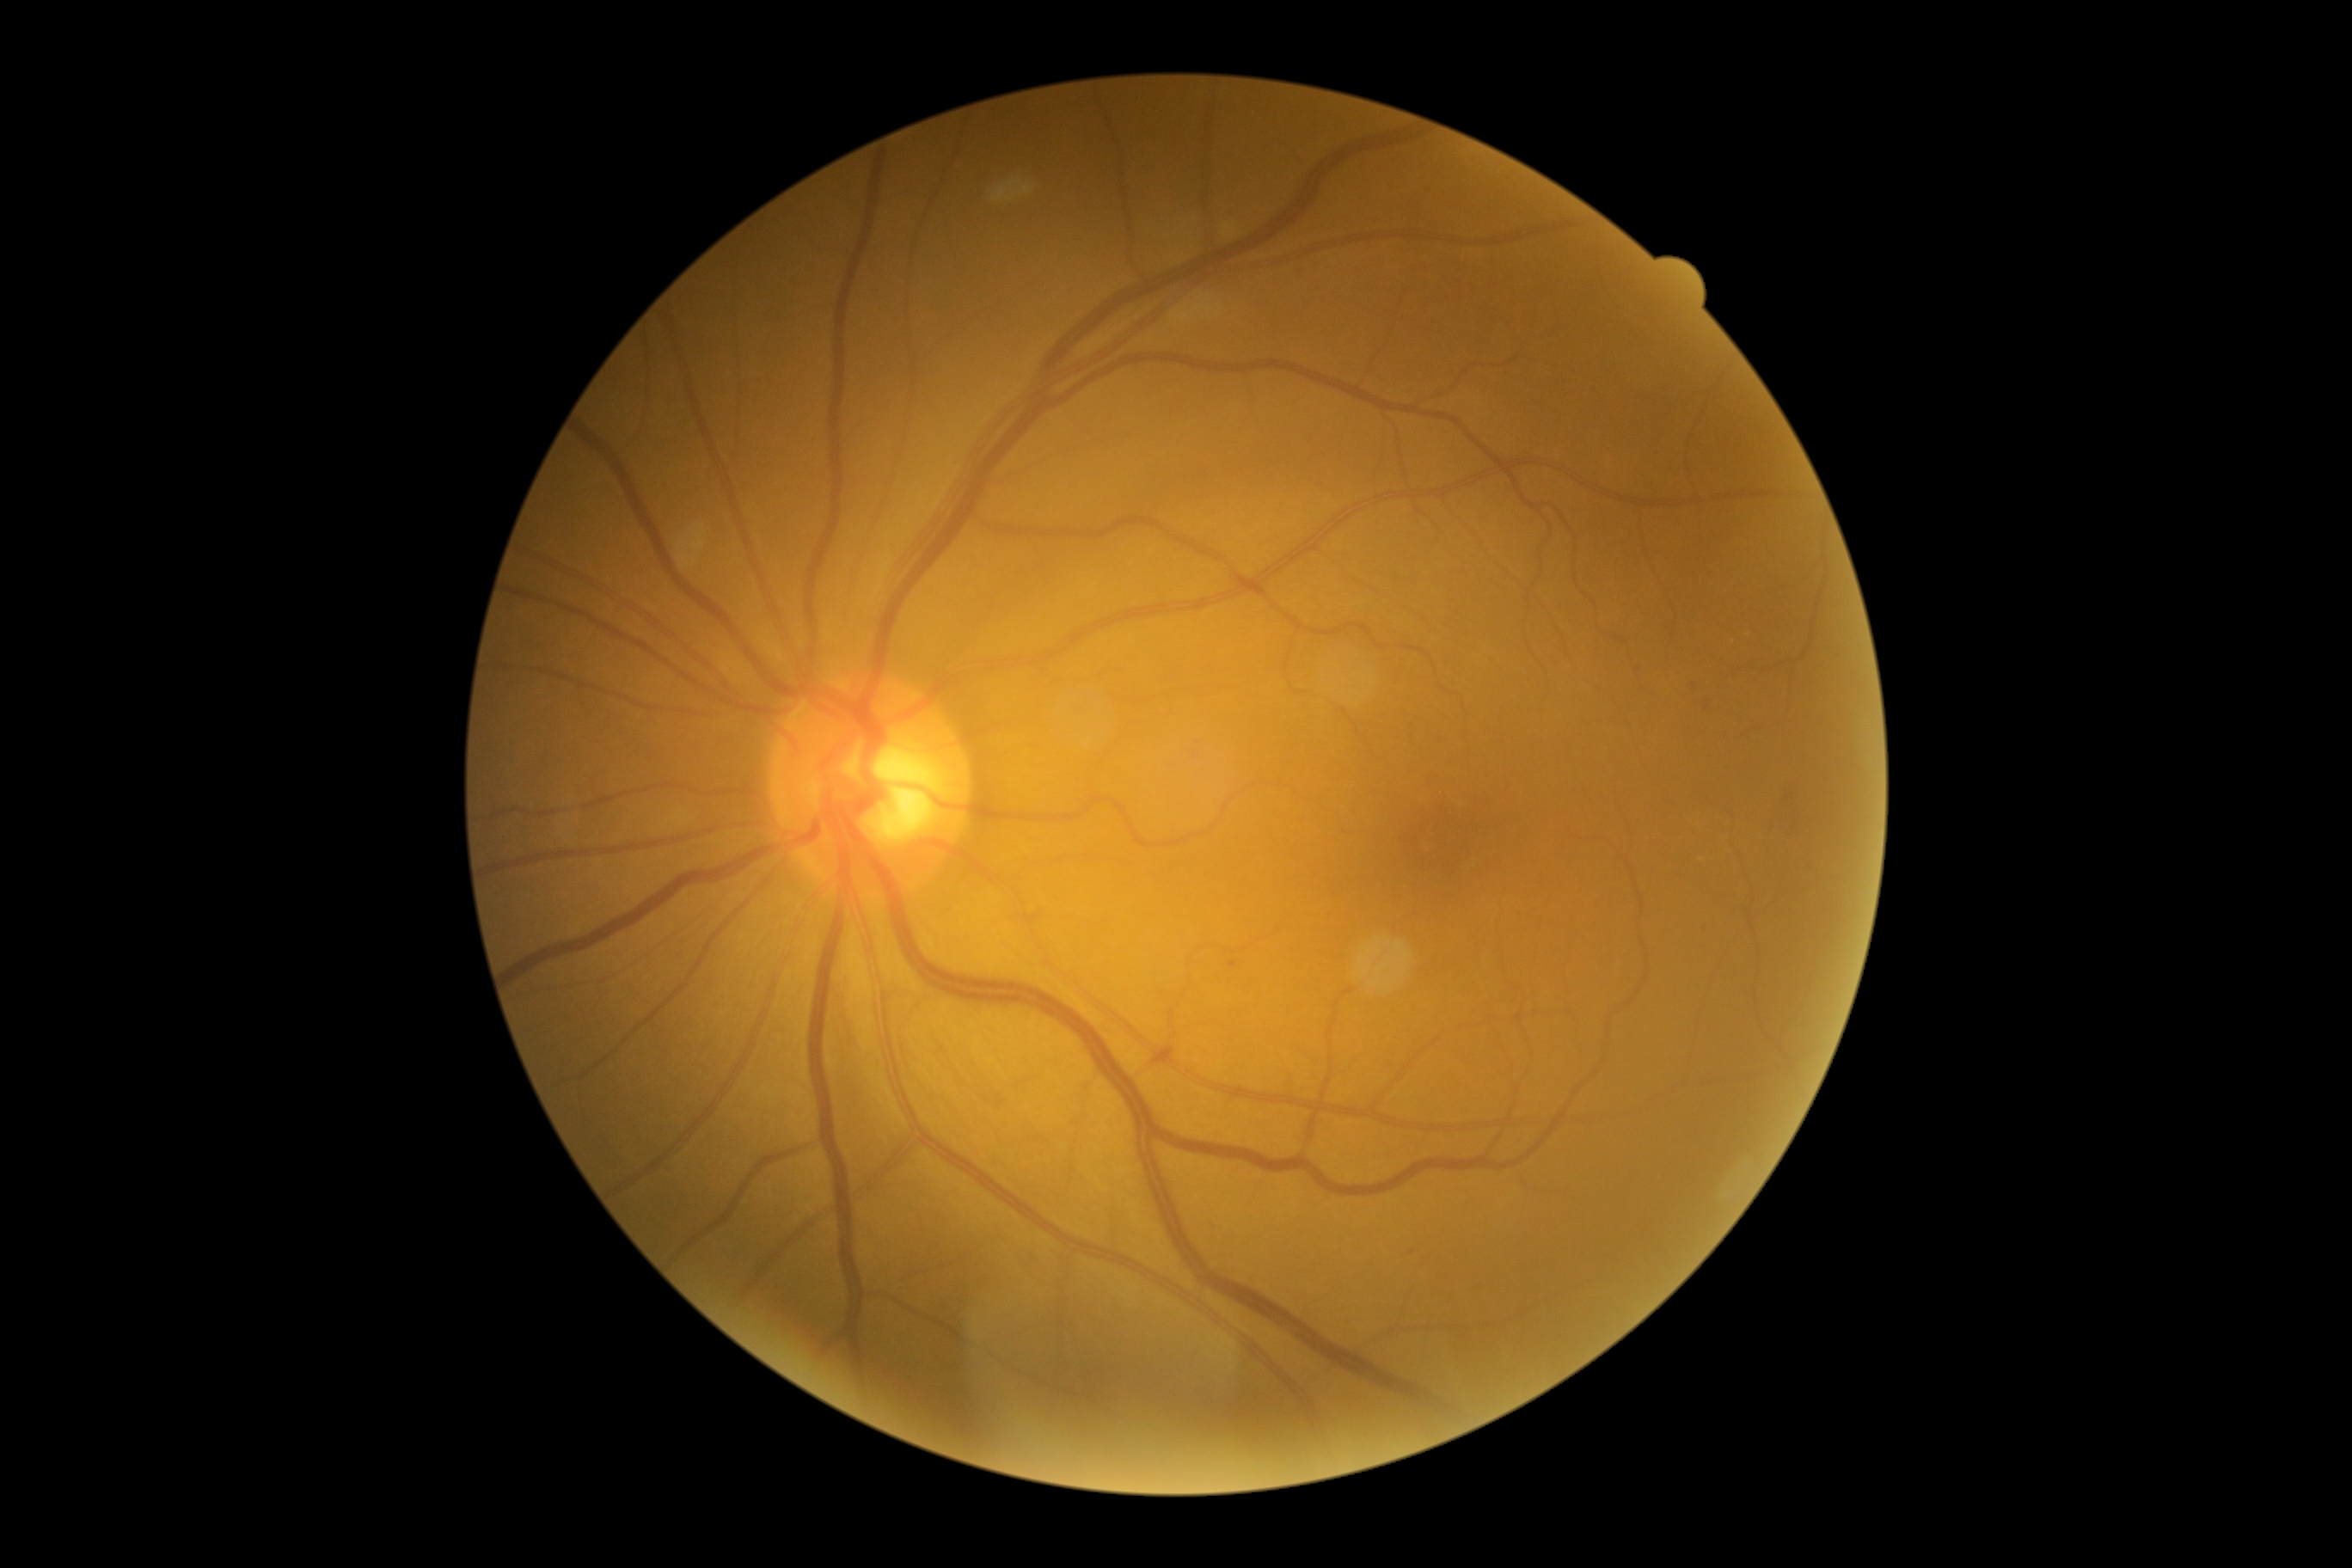
dr_grade: moderate non-proliferative diabetic retinopathy (2)